45° FOV — 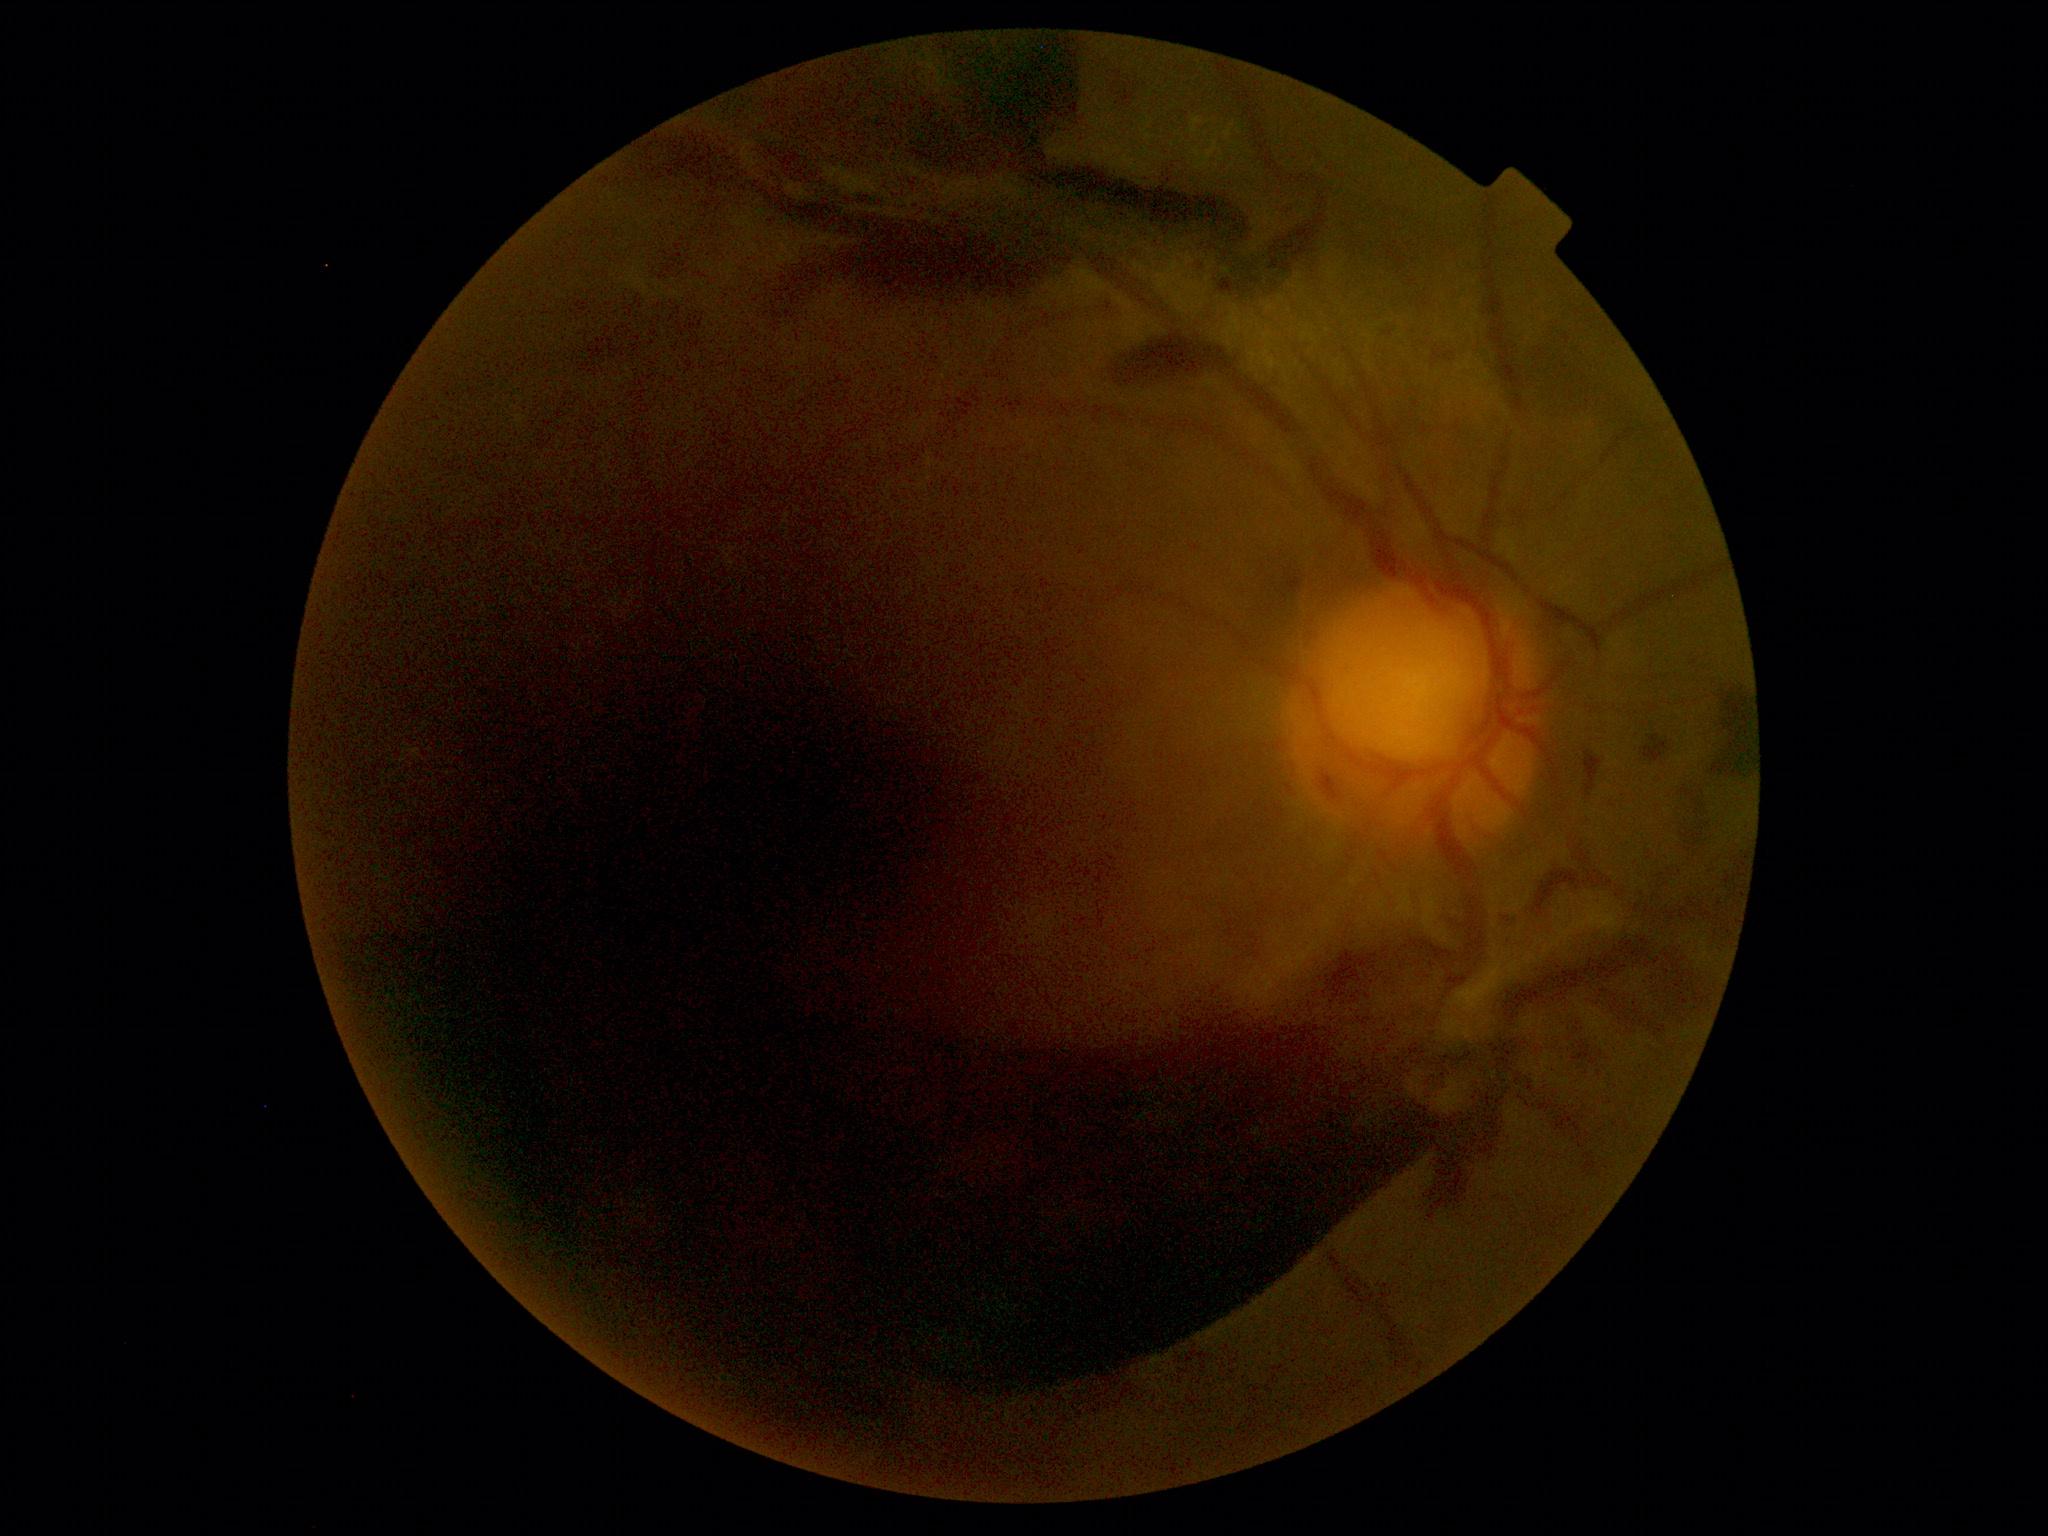

{
  "dr_grade": "PDR (grade 4)"
}